CFP; DR severity per modified Davis staging; no pharmacologic dilation; 45° field of view; camera: NIDEK AFC-230:
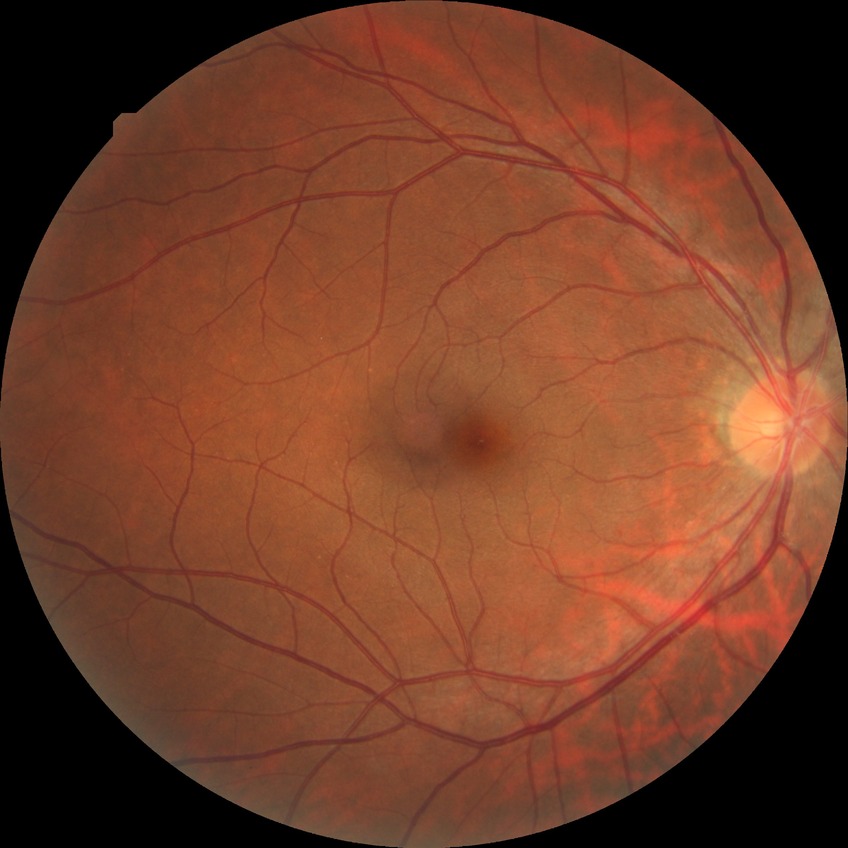 Diabetic retinopathy (DR) is NDR (no diabetic retinopathy).